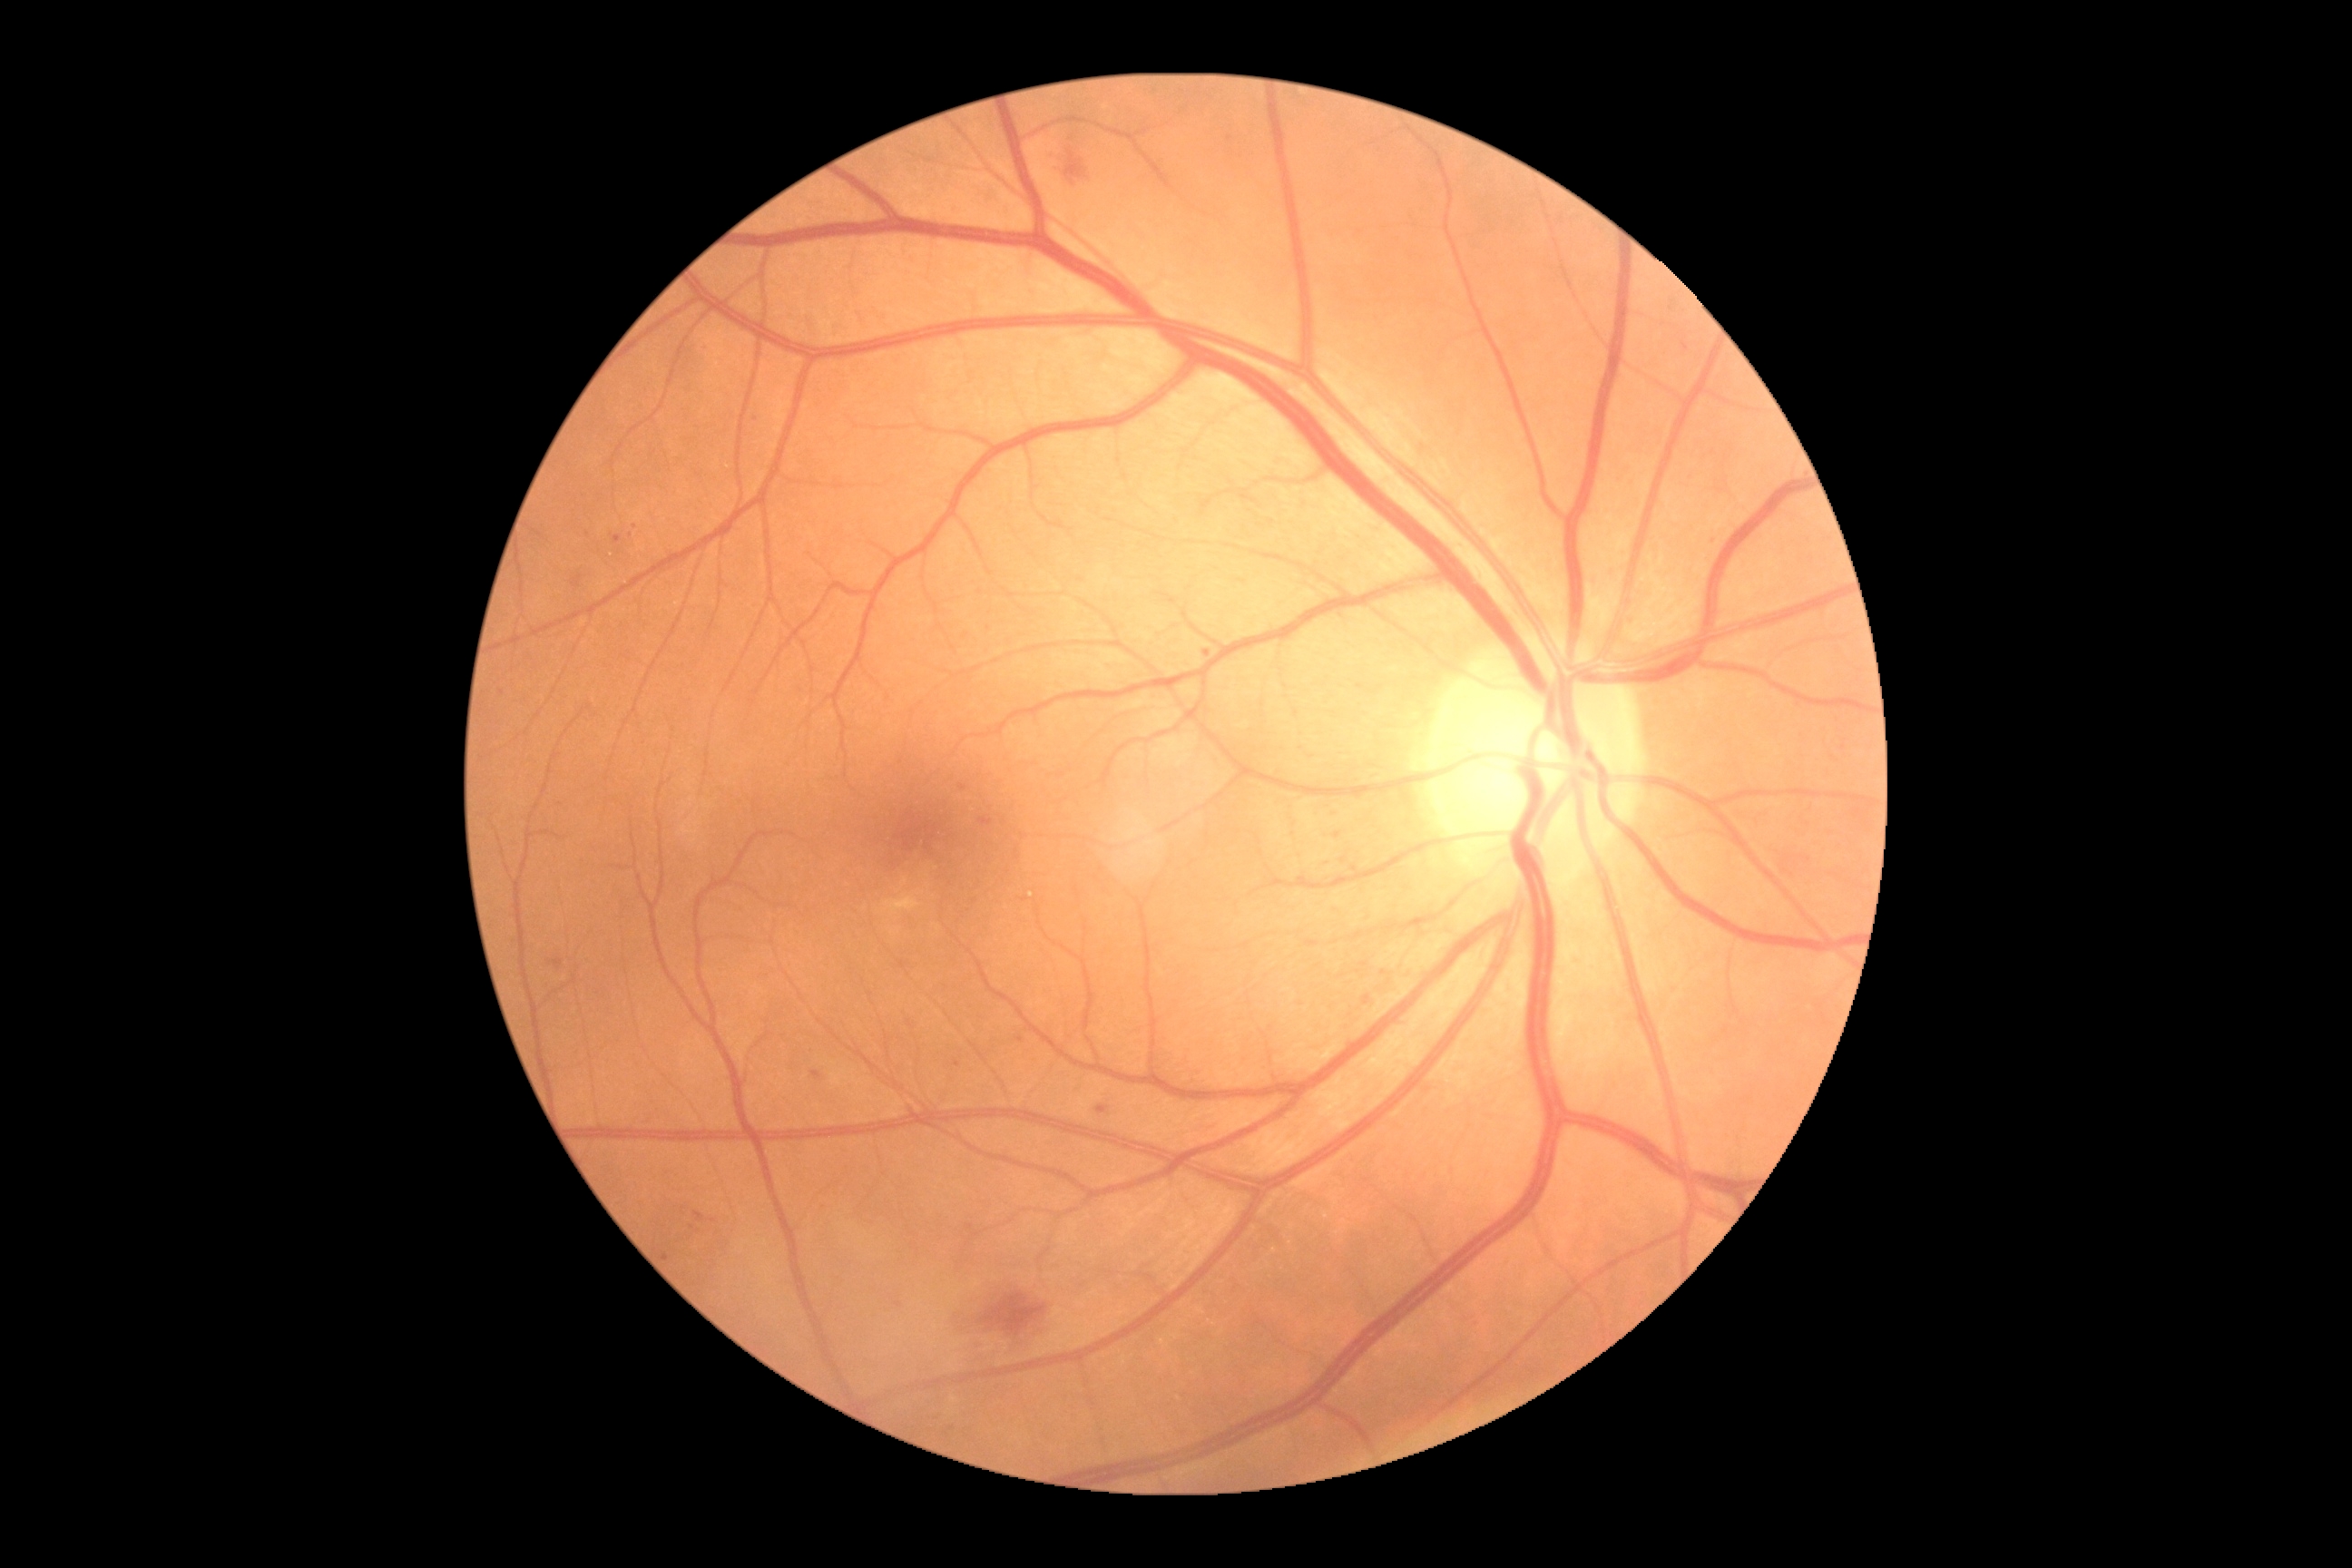 diabetic retinopathy (DR)@moderate non-proliferative diabetic retinopathy (grade 2) — more than just microaneurysms but less than severe NPDR.